45-degree field of view, image size 1725x1721, fundus photo.
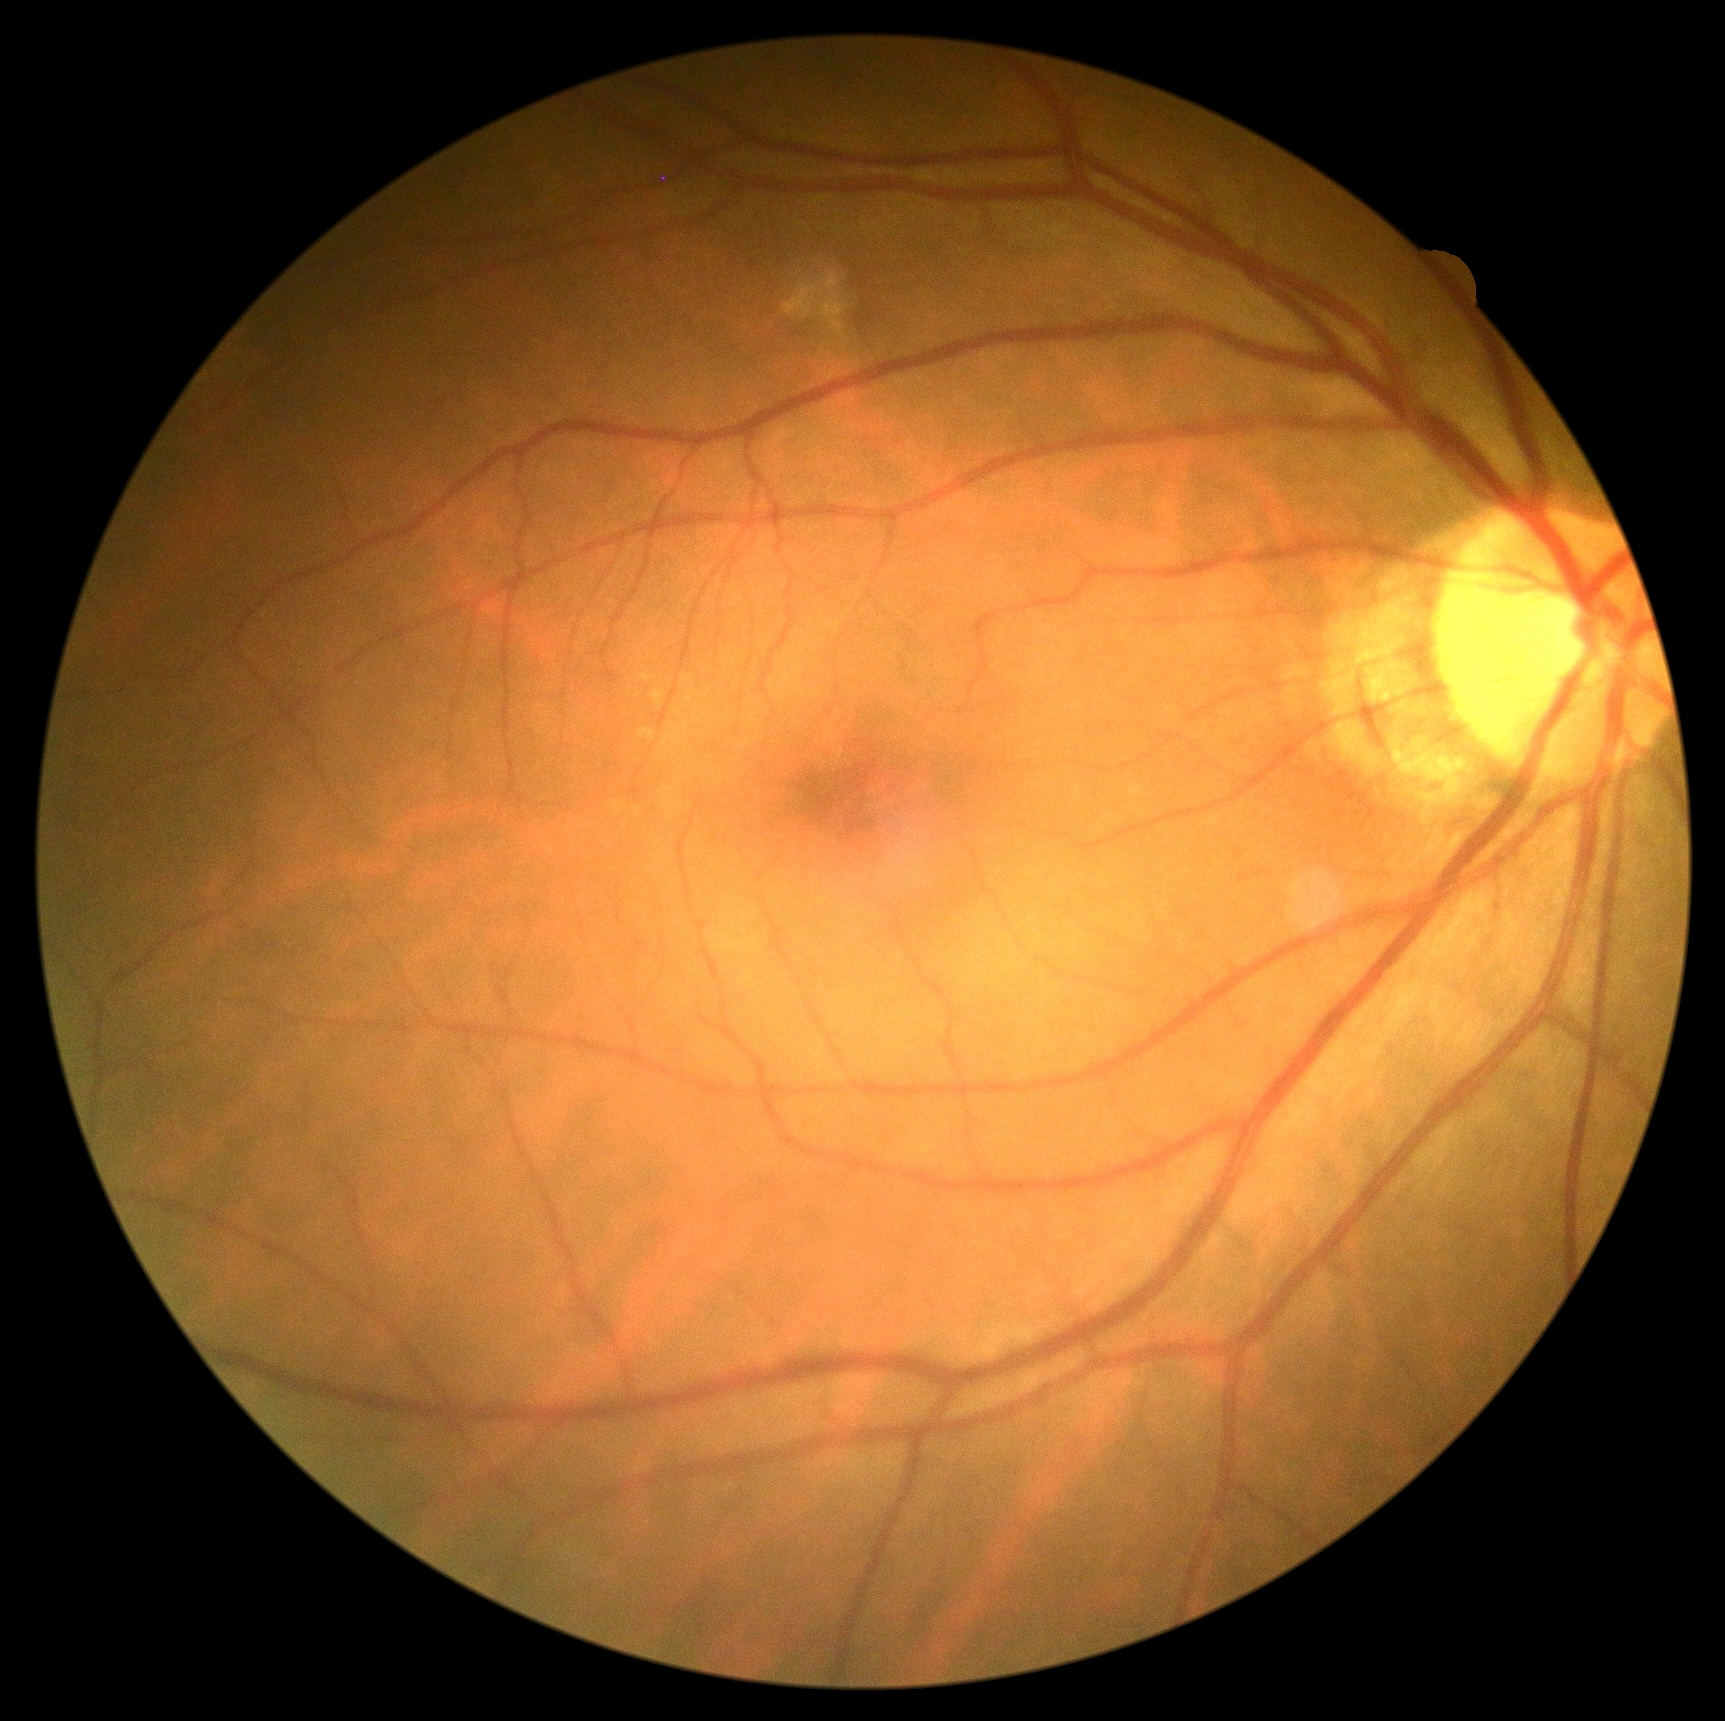
Annotations:
• diabetic retinopathy severity — grade 0